1932x1932px, CFP, FOV: 45 degrees — 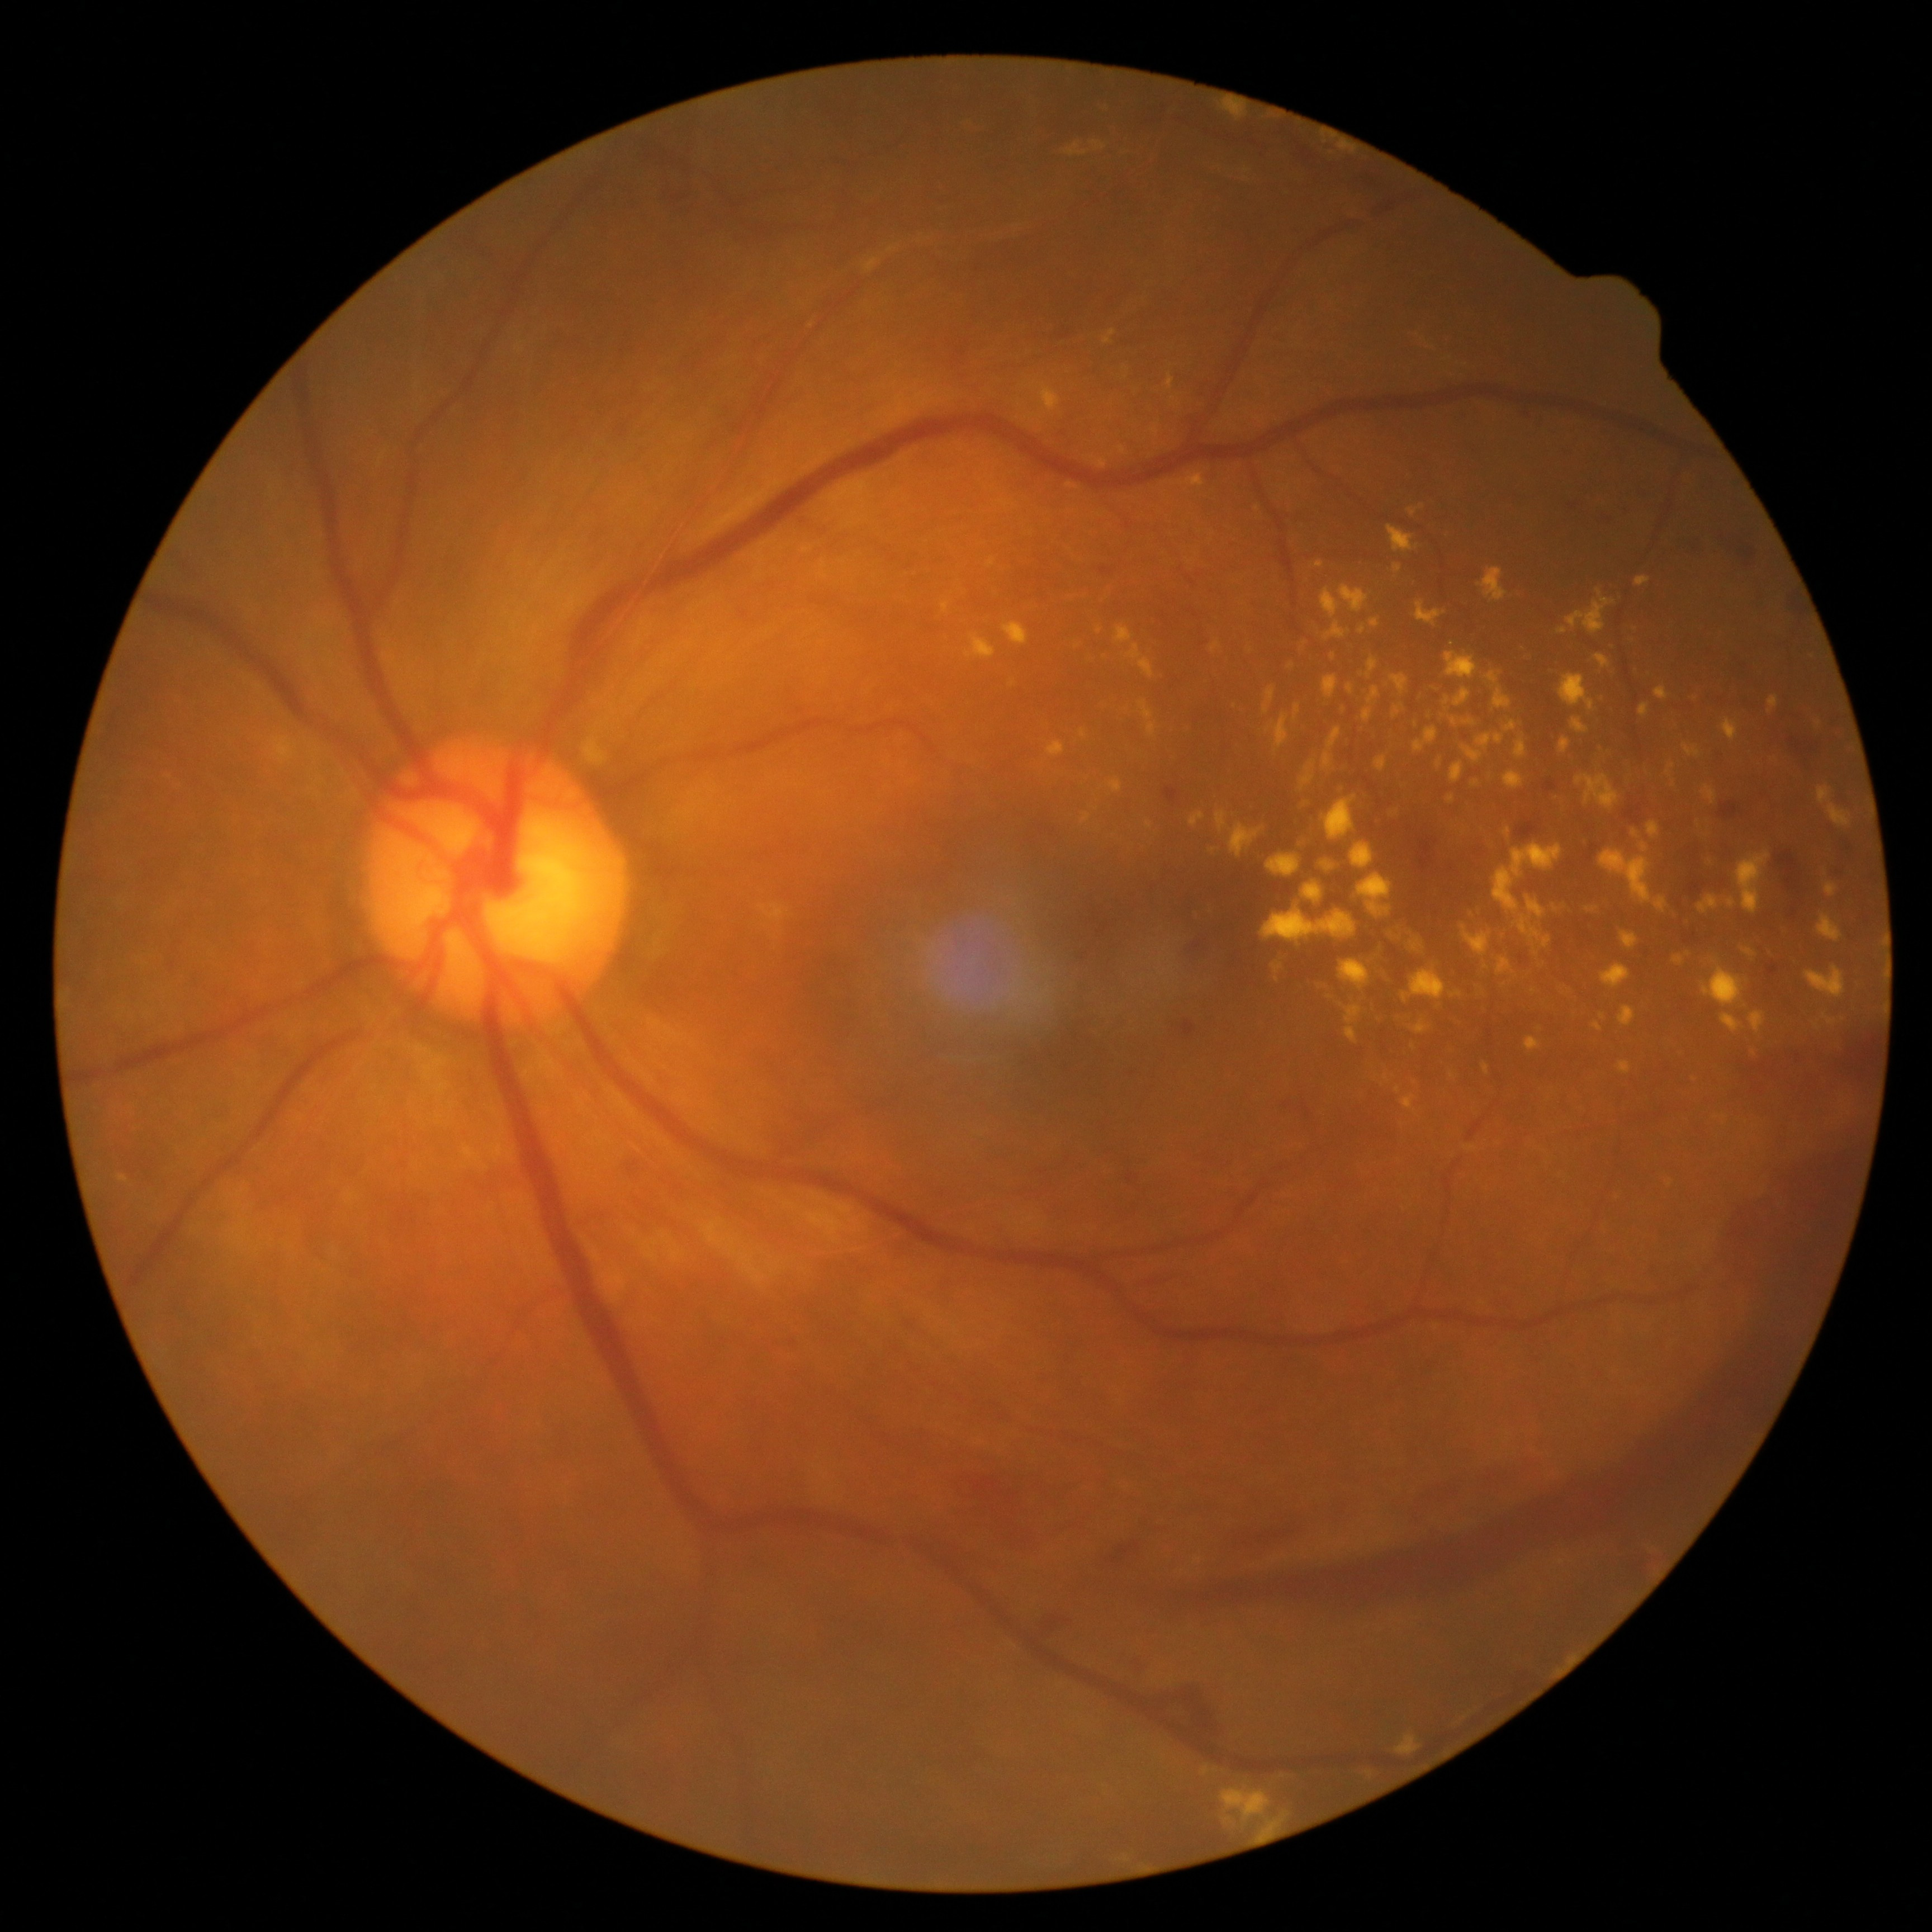

Diabetic retinopathy grade is 4
Lesions identified (partial list):
microaneurysms: none identified
hemorrhages (more not shown): [1162, 787, 1180, 804] | [1723, 546, 1765, 575] | [1182, 1020, 1197, 1038] | [1684, 934, 1697, 945] | [1240, 1500, 1344, 1547] | [1139, 1124, 1870, 1614] | [1767, 963, 1779, 978] | [1792, 910, 1797, 918] | [1594, 512, 1617, 529] | [1666, 535, 1708, 557] | [1782, 588, 1807, 614] | [952, 1464, 1053, 1559] | [1093, 1531, 1144, 1570] | [1718, 801, 1738, 819]
hard exudates (more not shown): [1351, 842, 1374, 869] | [1413, 937, 1422, 950] | [1289, 662, 1295, 670] | [1823, 1014, 1838, 1026] | [1139, 700, 1153, 721] | [1149, 723, 1156, 736] | [1339, 143, 1357, 154] | [1391, 676, 1409, 694] | [1220, 1788, 1271, 1822] | [1362, 709, 1374, 722] | [1109, 778, 1123, 794] | [1720, 1014, 1744, 1033] | [1224, 1816, 1233, 1824] | [1339, 585, 1369, 612] | [1263, 688, 1276, 715] | [1022, 383, 1062, 411] | [1493, 845, 1564, 916]
Smaller hard exudates around x=1487, y=966 | x=1013, y=684 | x=1126, y=1859
soft exudates: none identified